Non-mydriatic; optic disc region crop:
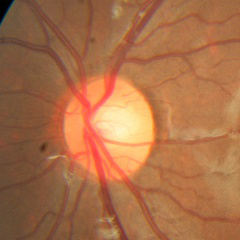

Diagnosis = no glaucomatous changes.